No pharmacologic dilation:
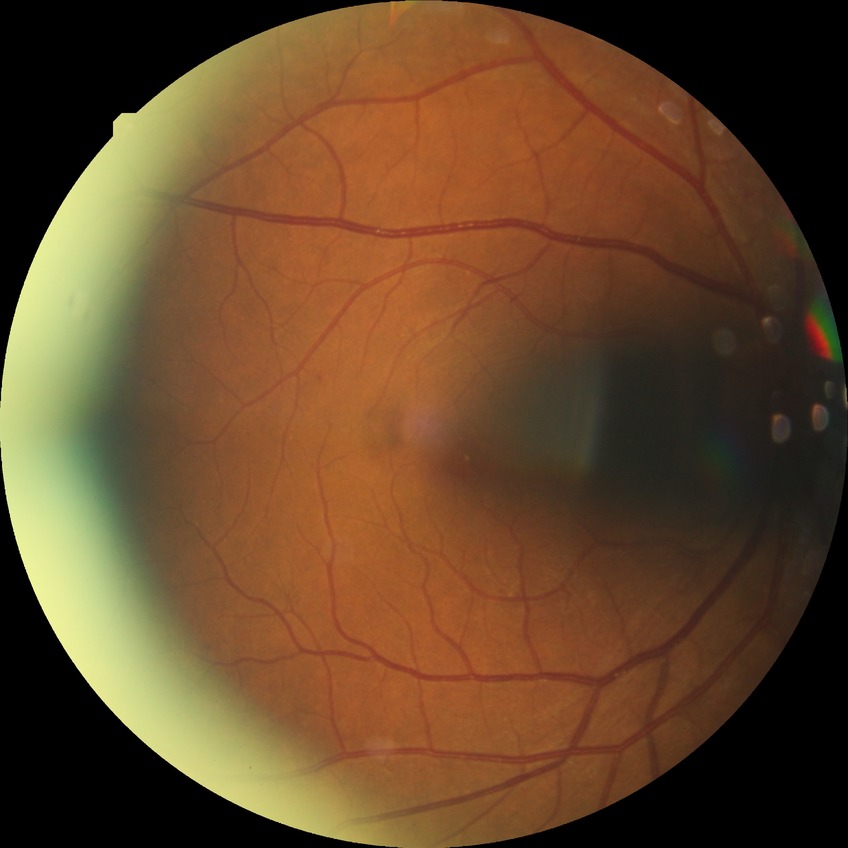
Diabetic retinopathy (DR): SDR (simple diabetic retinopathy).